2352 x 1568 pixels · fundus photo: 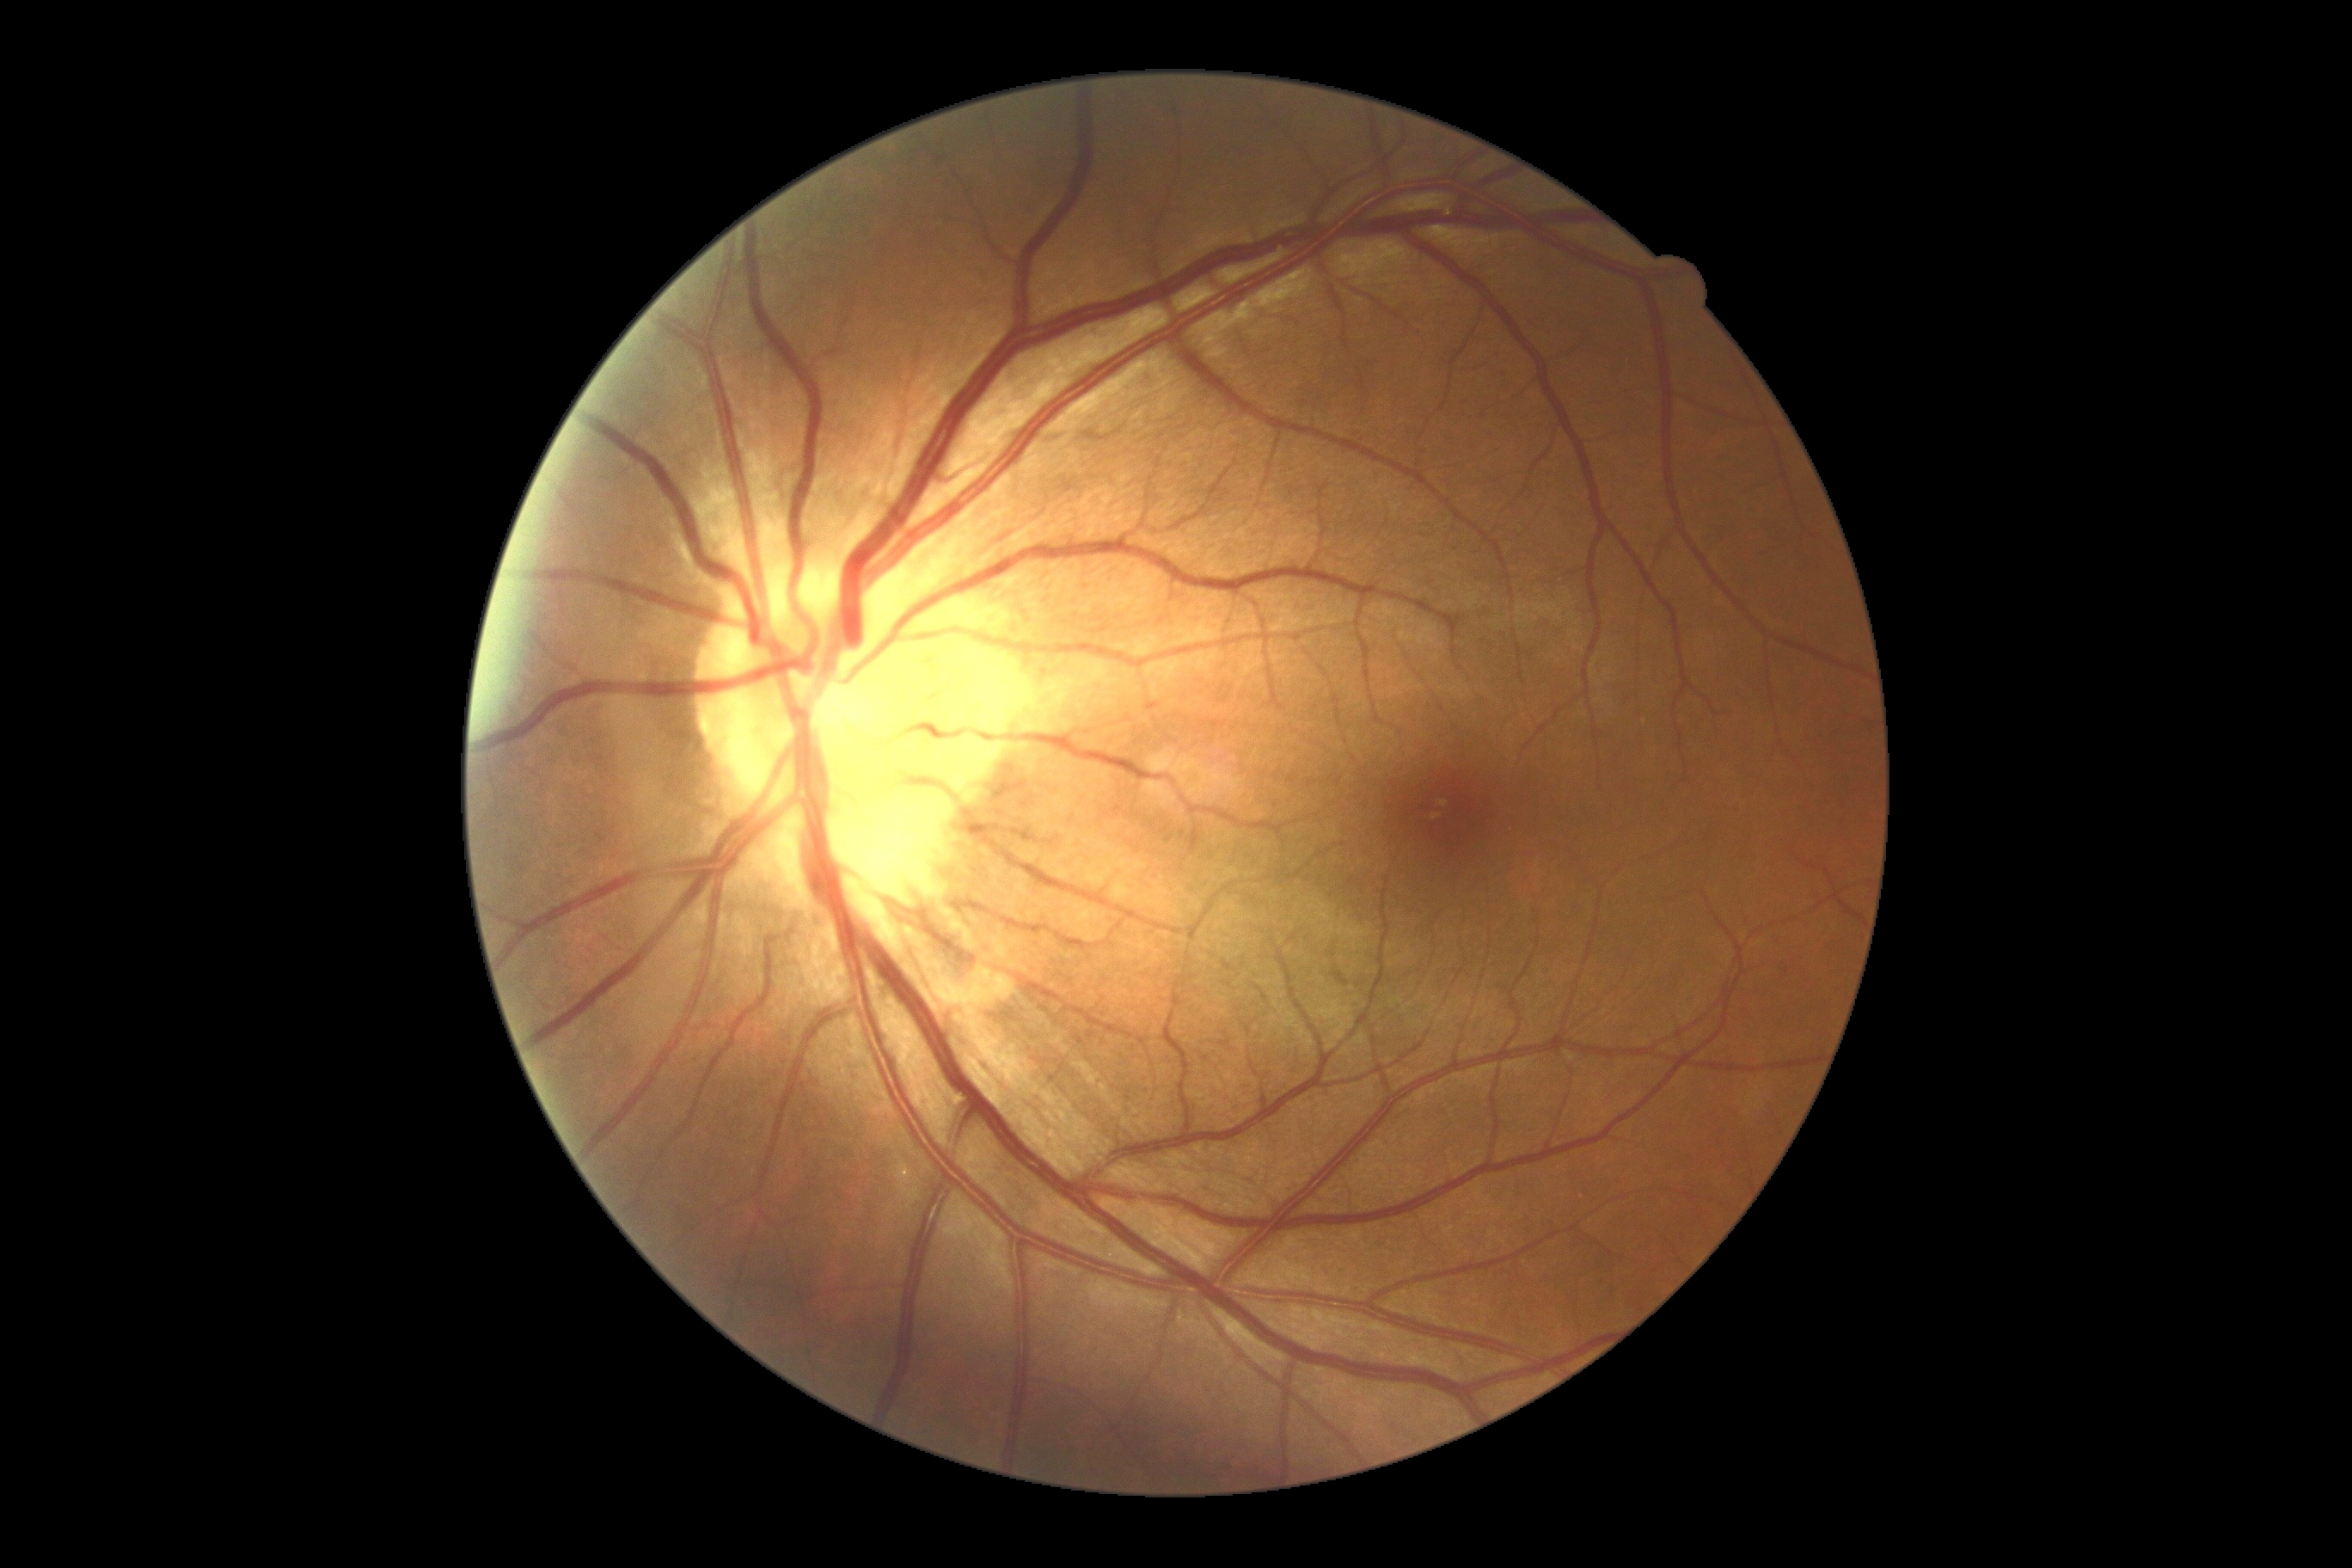
Diabetic retinopathy severity is no apparent retinopathy (grade 0).